Modified Davis grading — 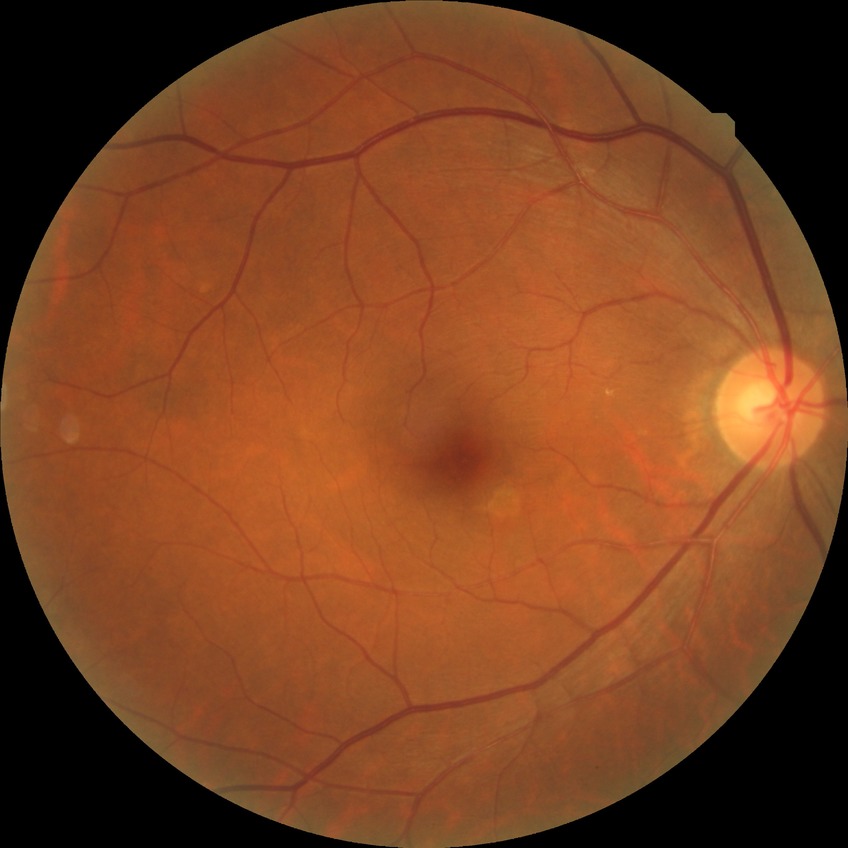
Diabetic retinopathy (DR) is NDR (no diabetic retinopathy).